100° field of view (Phoenix ICON). Pediatric retinal photograph (wide-field). 1240 by 1240 pixels: 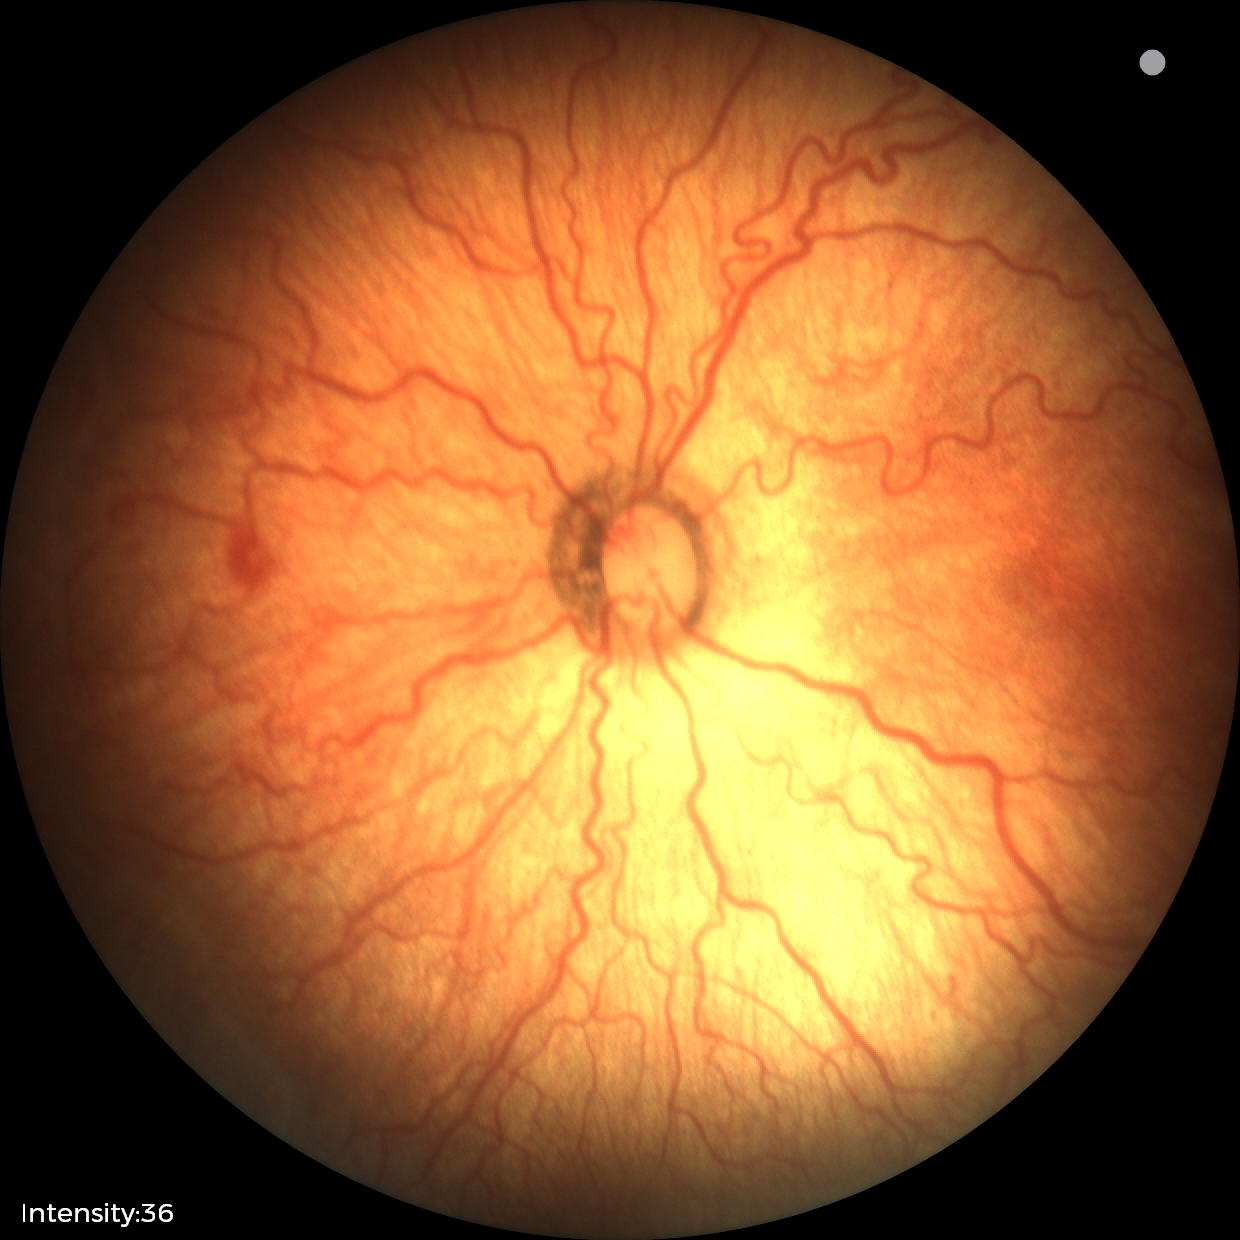 Plus disease present. Series diagnosed as retinopathy of prematurity (ROP) stage 2.